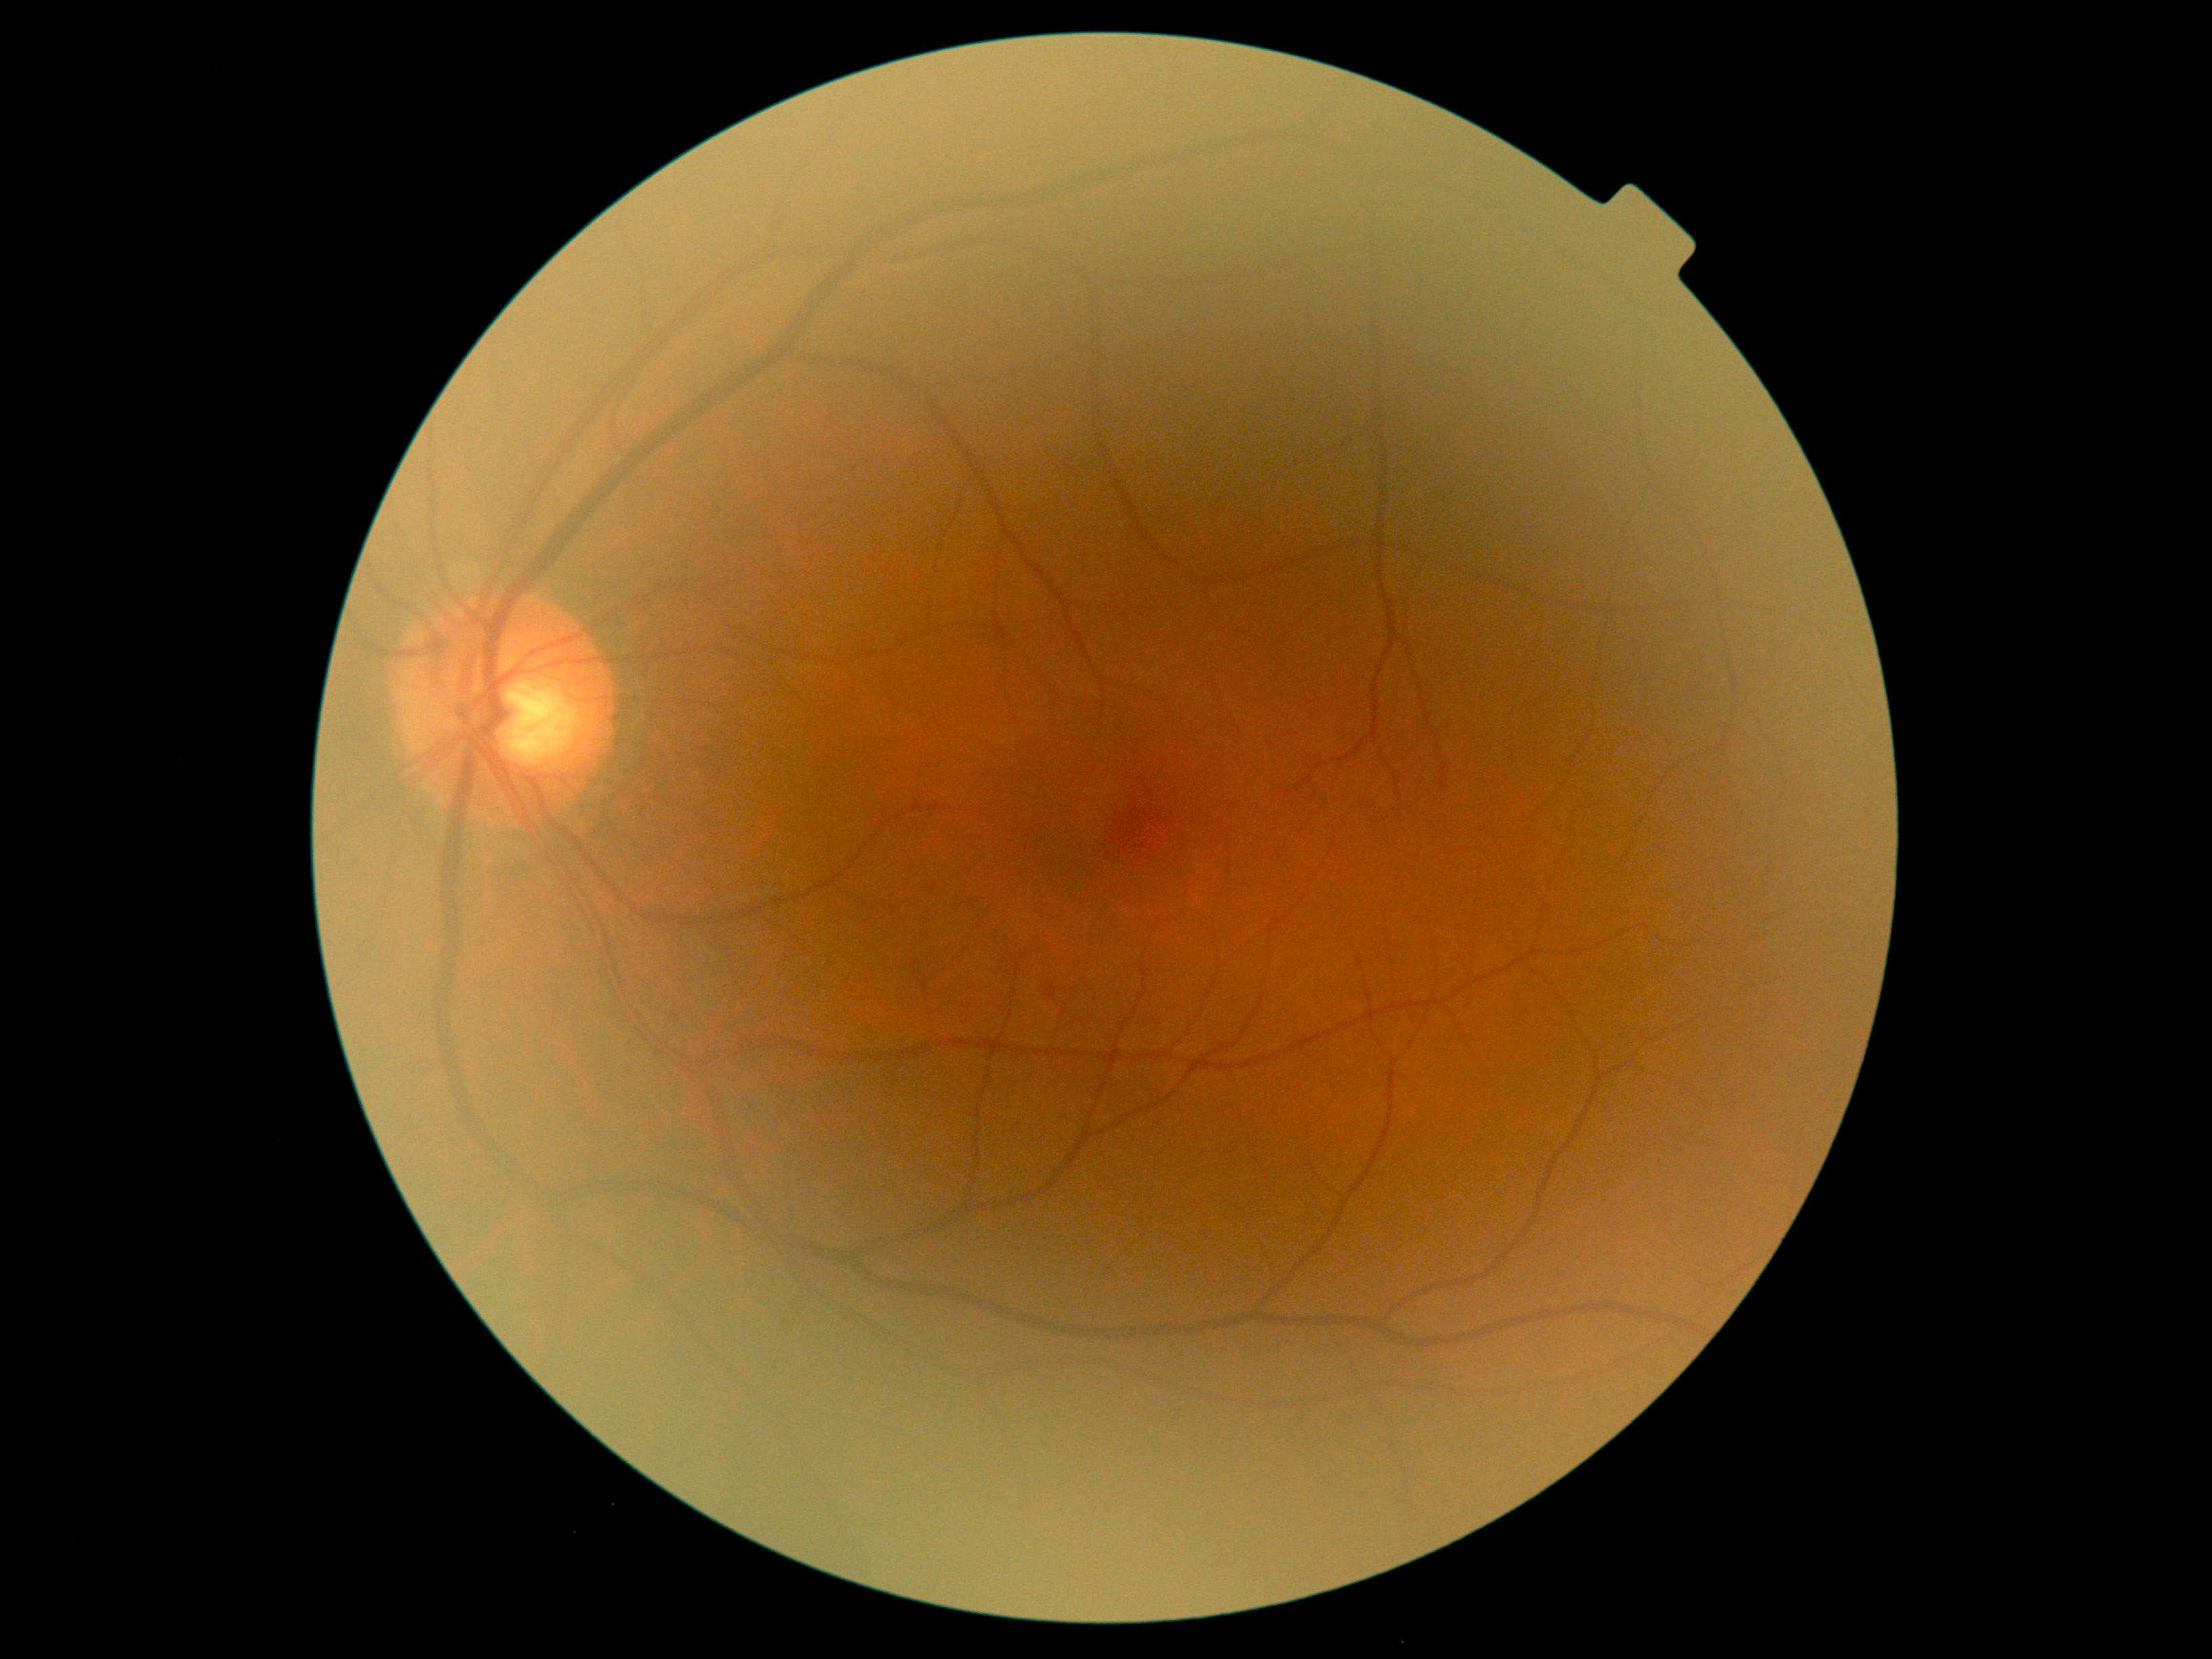
– DR class: non-proliferative diabetic retinopathy
– DR severity: grade 1 — presence of microaneurysms only